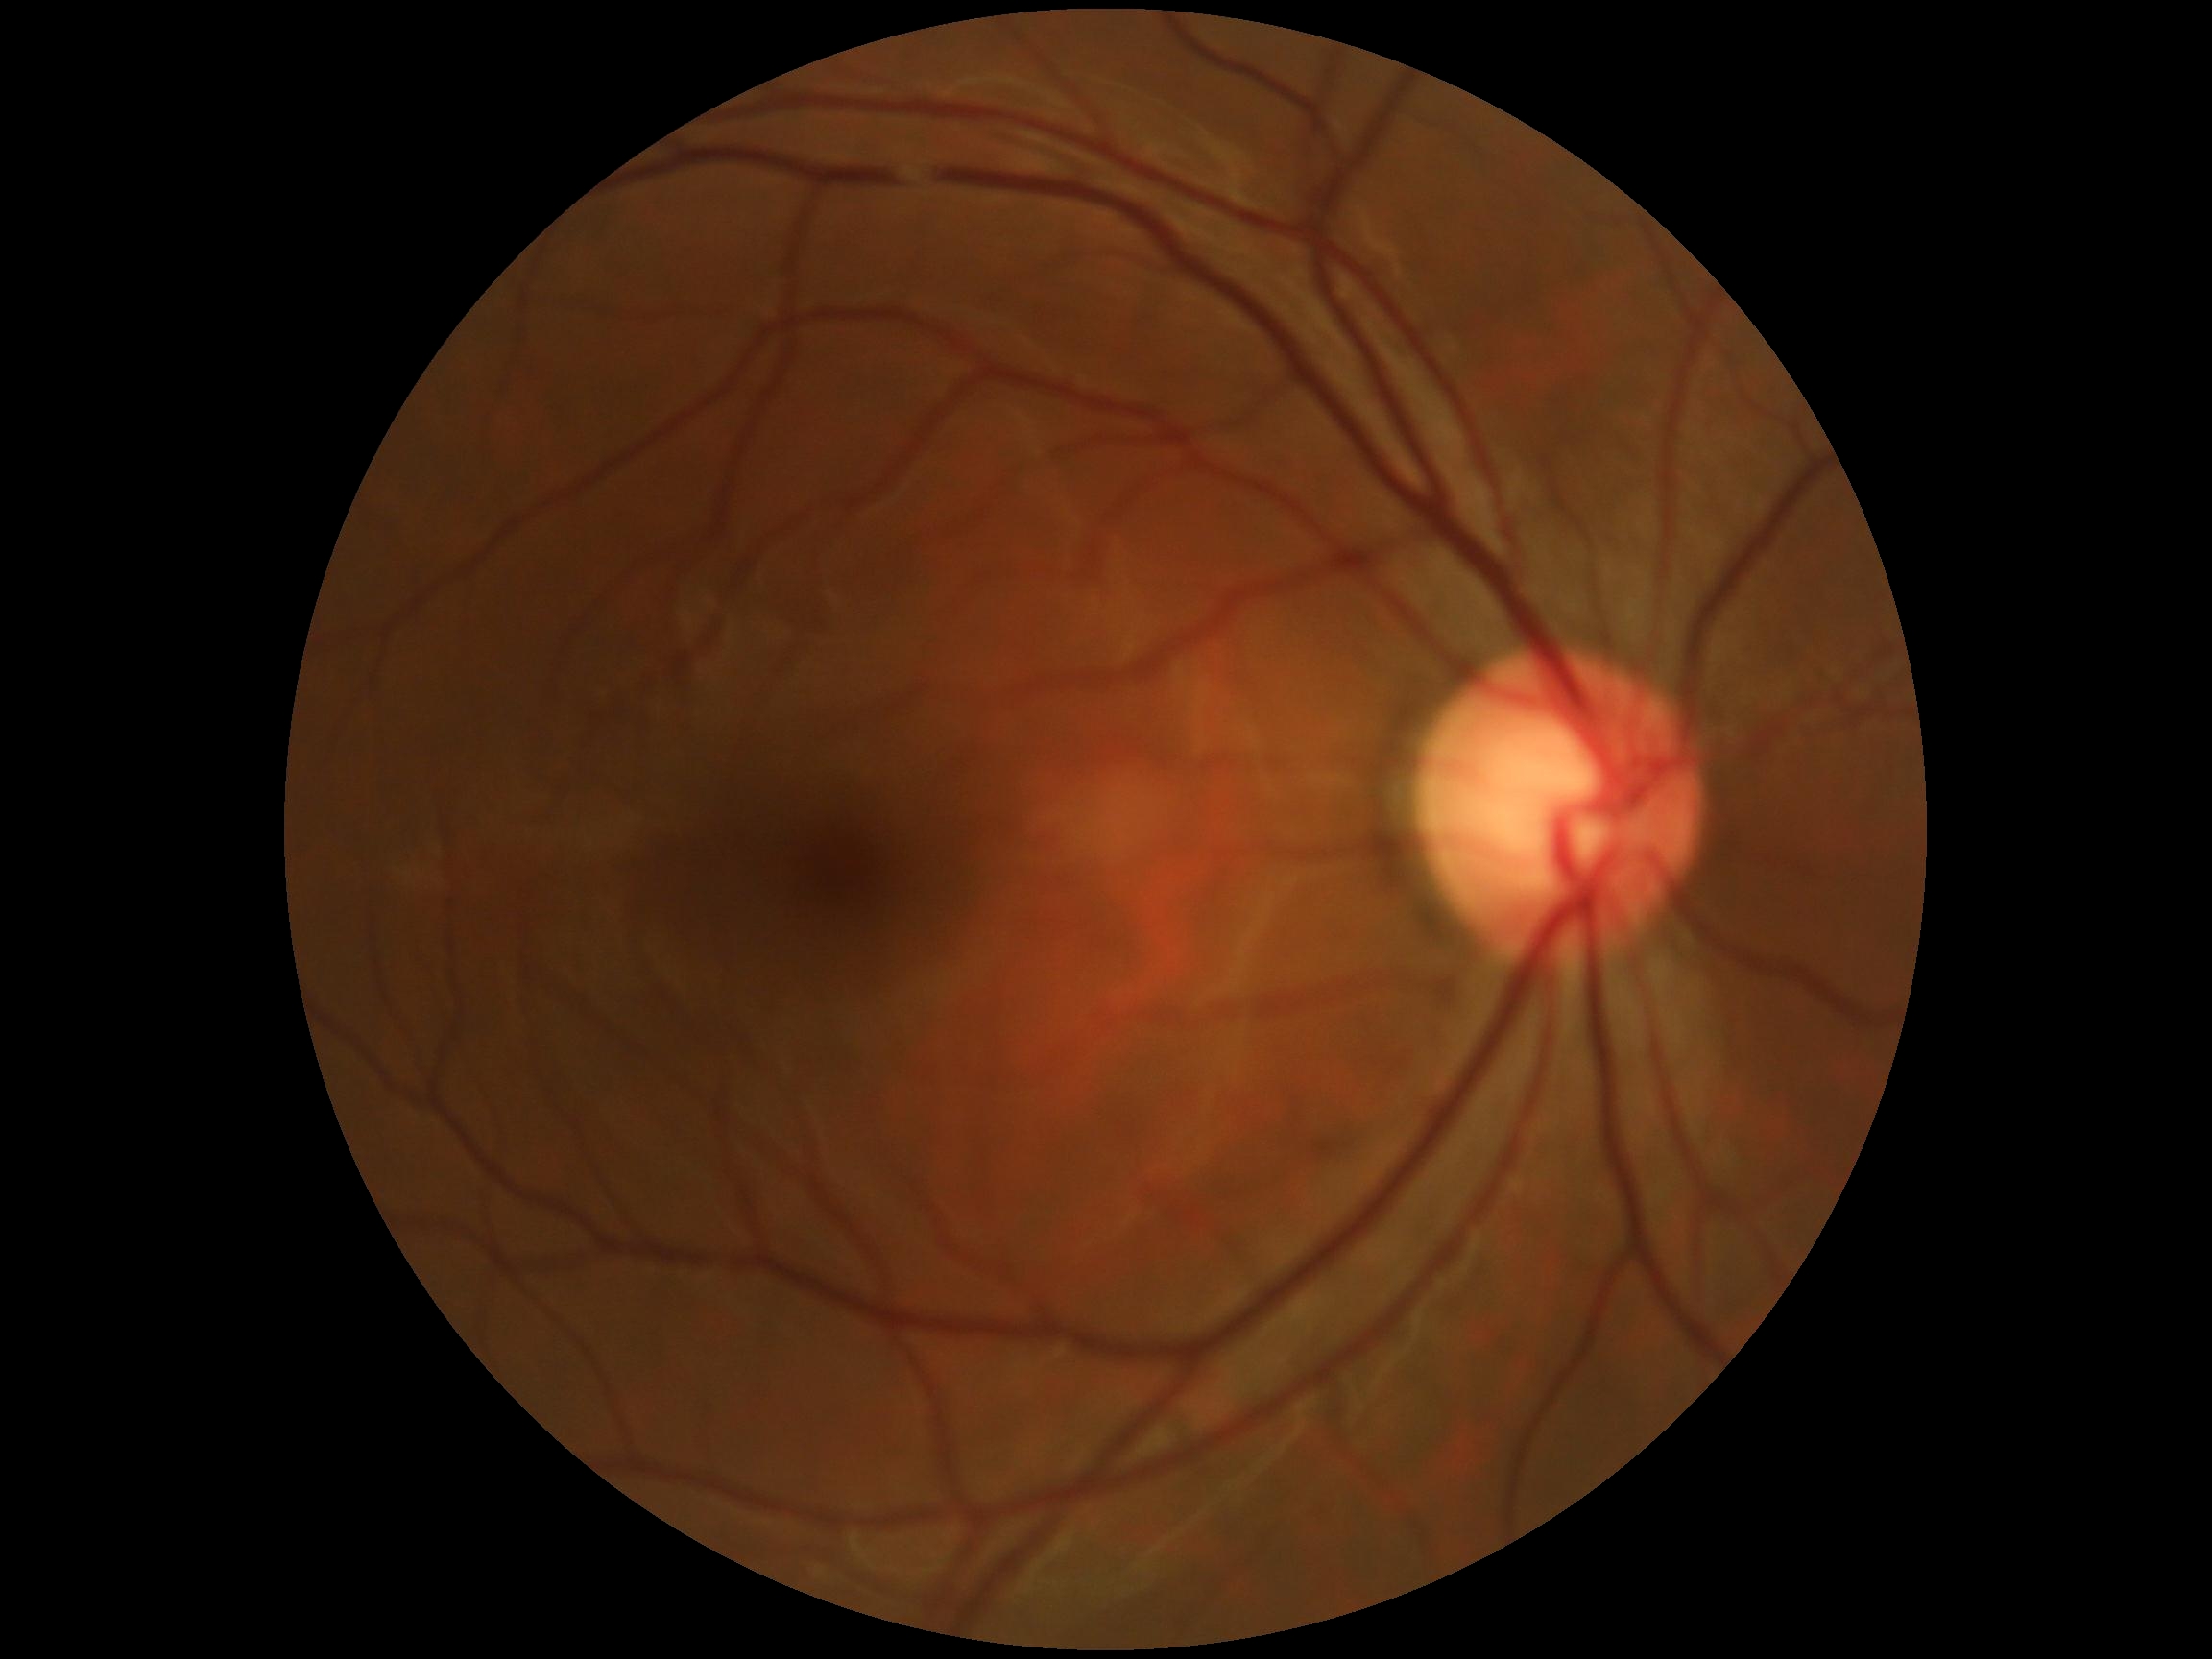

DR stage: no apparent retinopathy (grade 0).